FOV: 50 degrees.
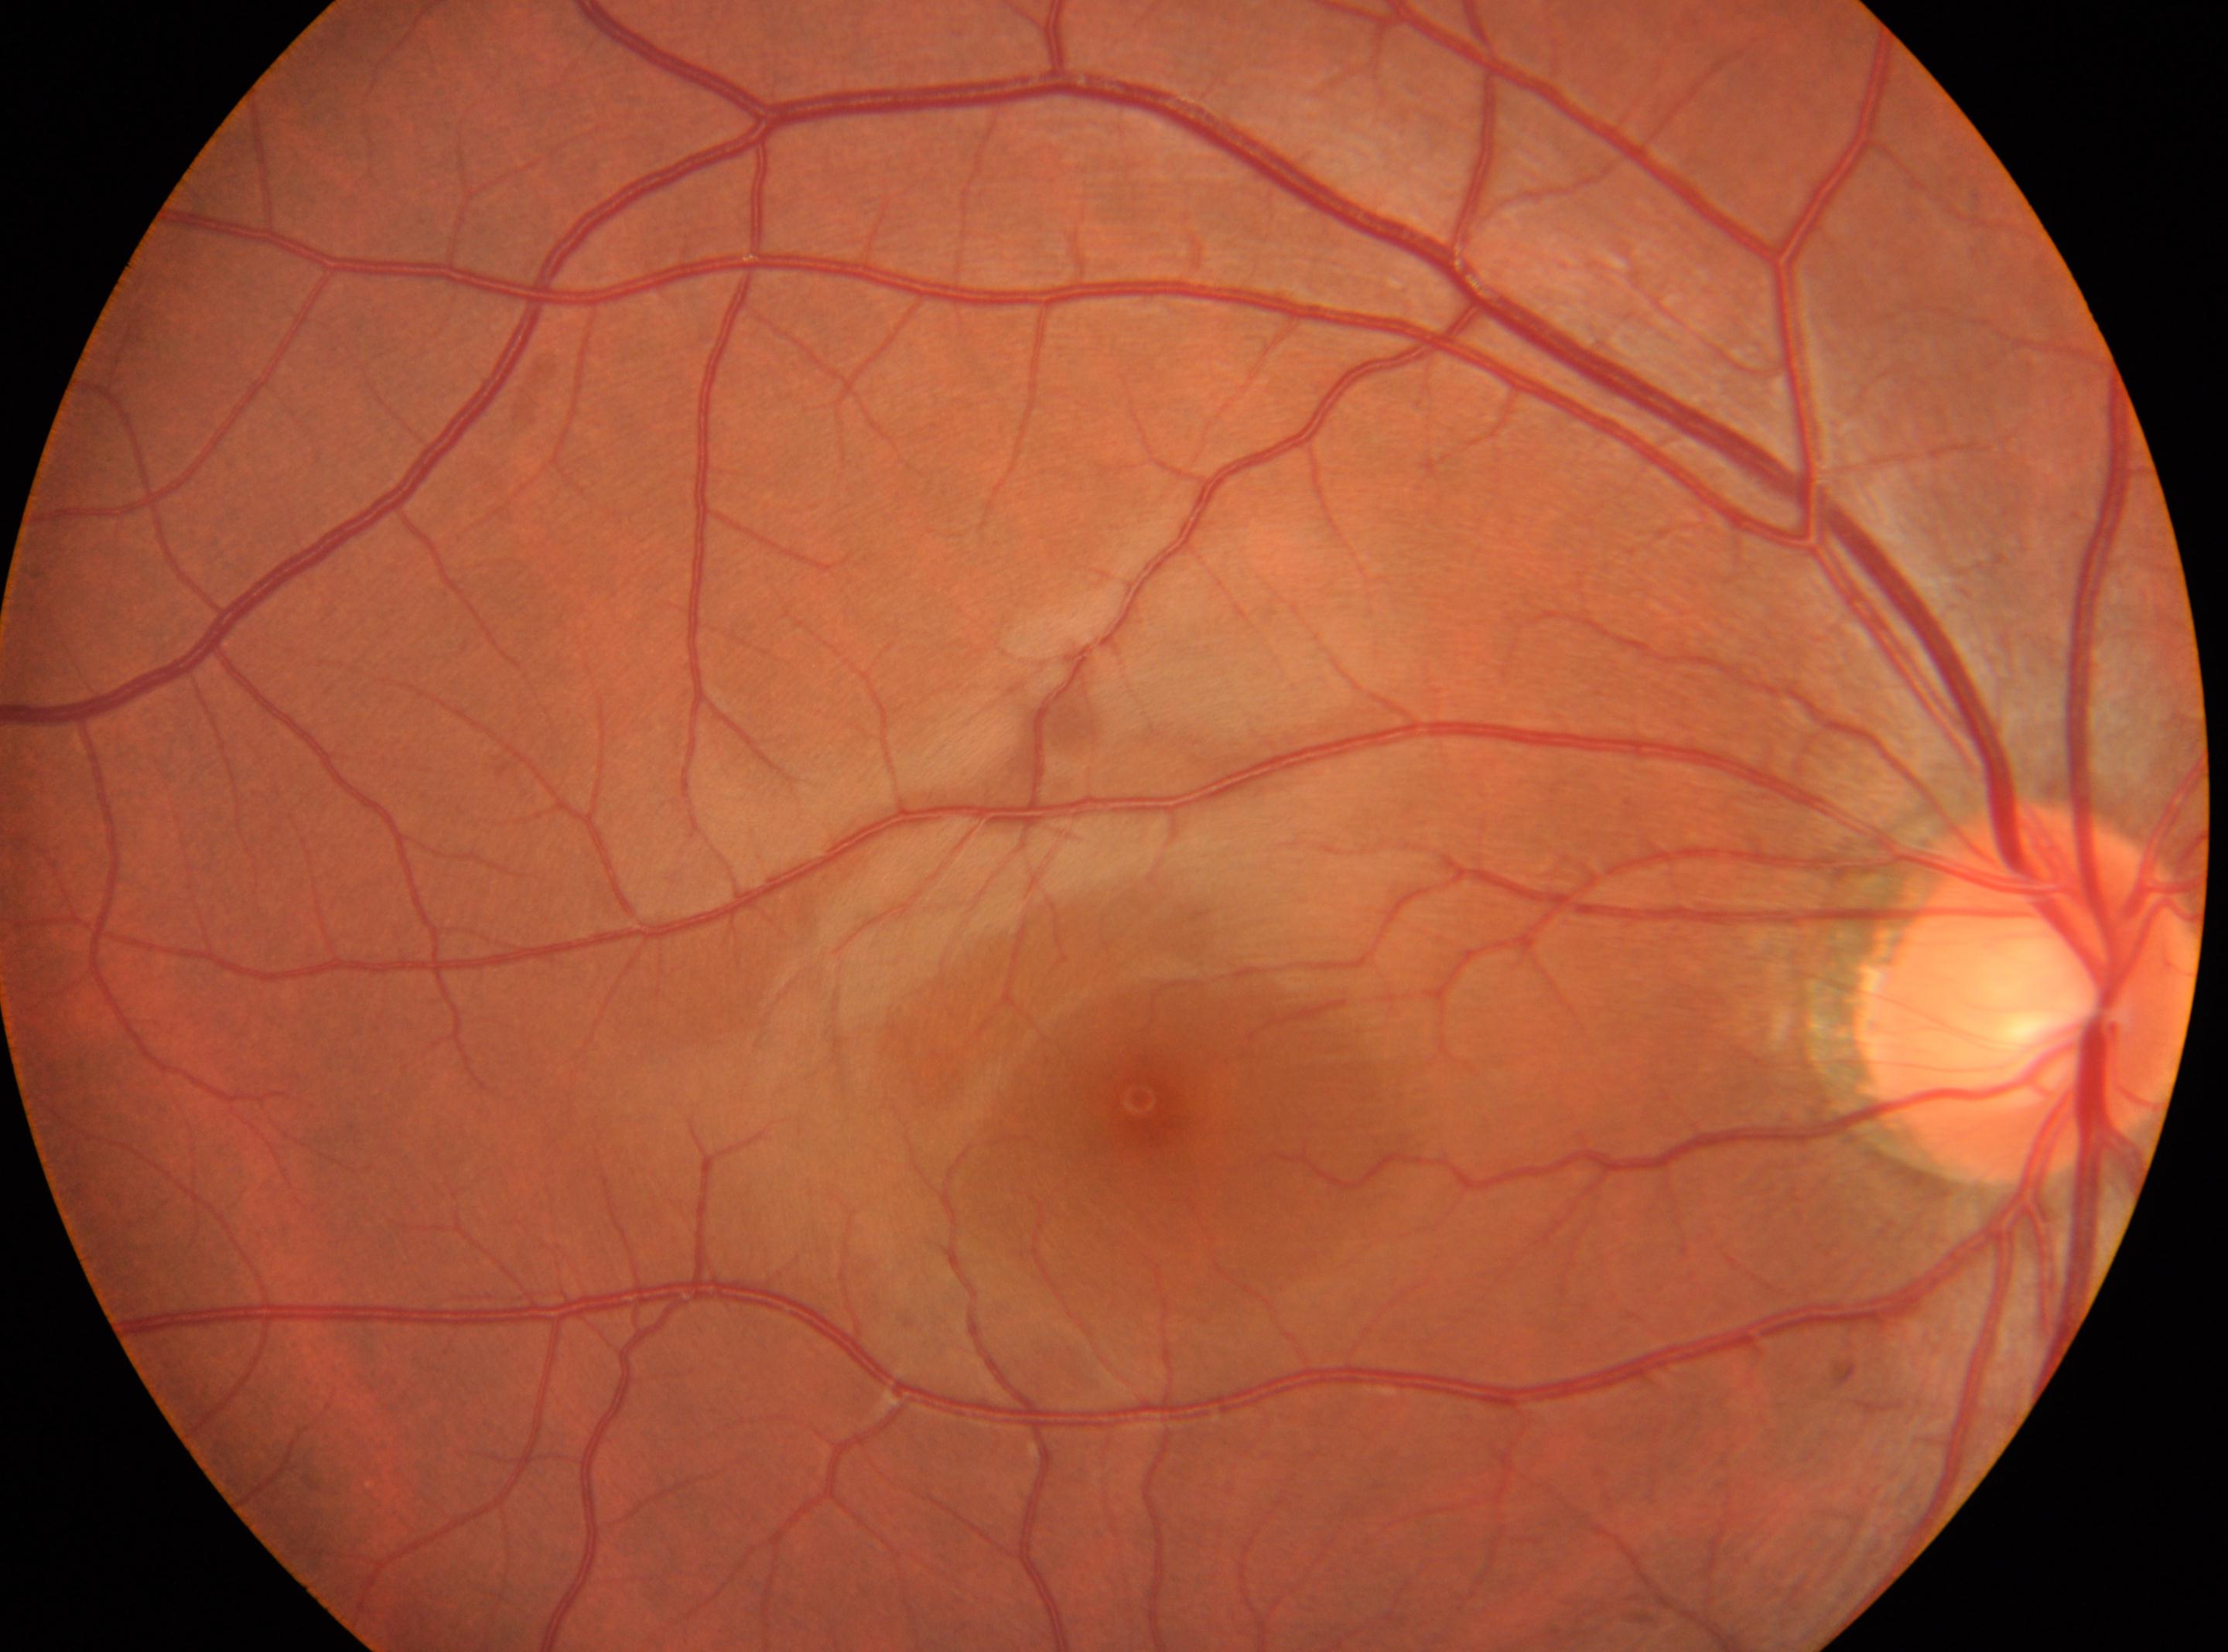

Diabetic retinopathy (DR): 0/4. Foveal center located at x=1148, y=1106. Imaged eye: right eye. Optic disc located at x=2033, y=992.